45° FOV; CFP; image size 2048x1536 — 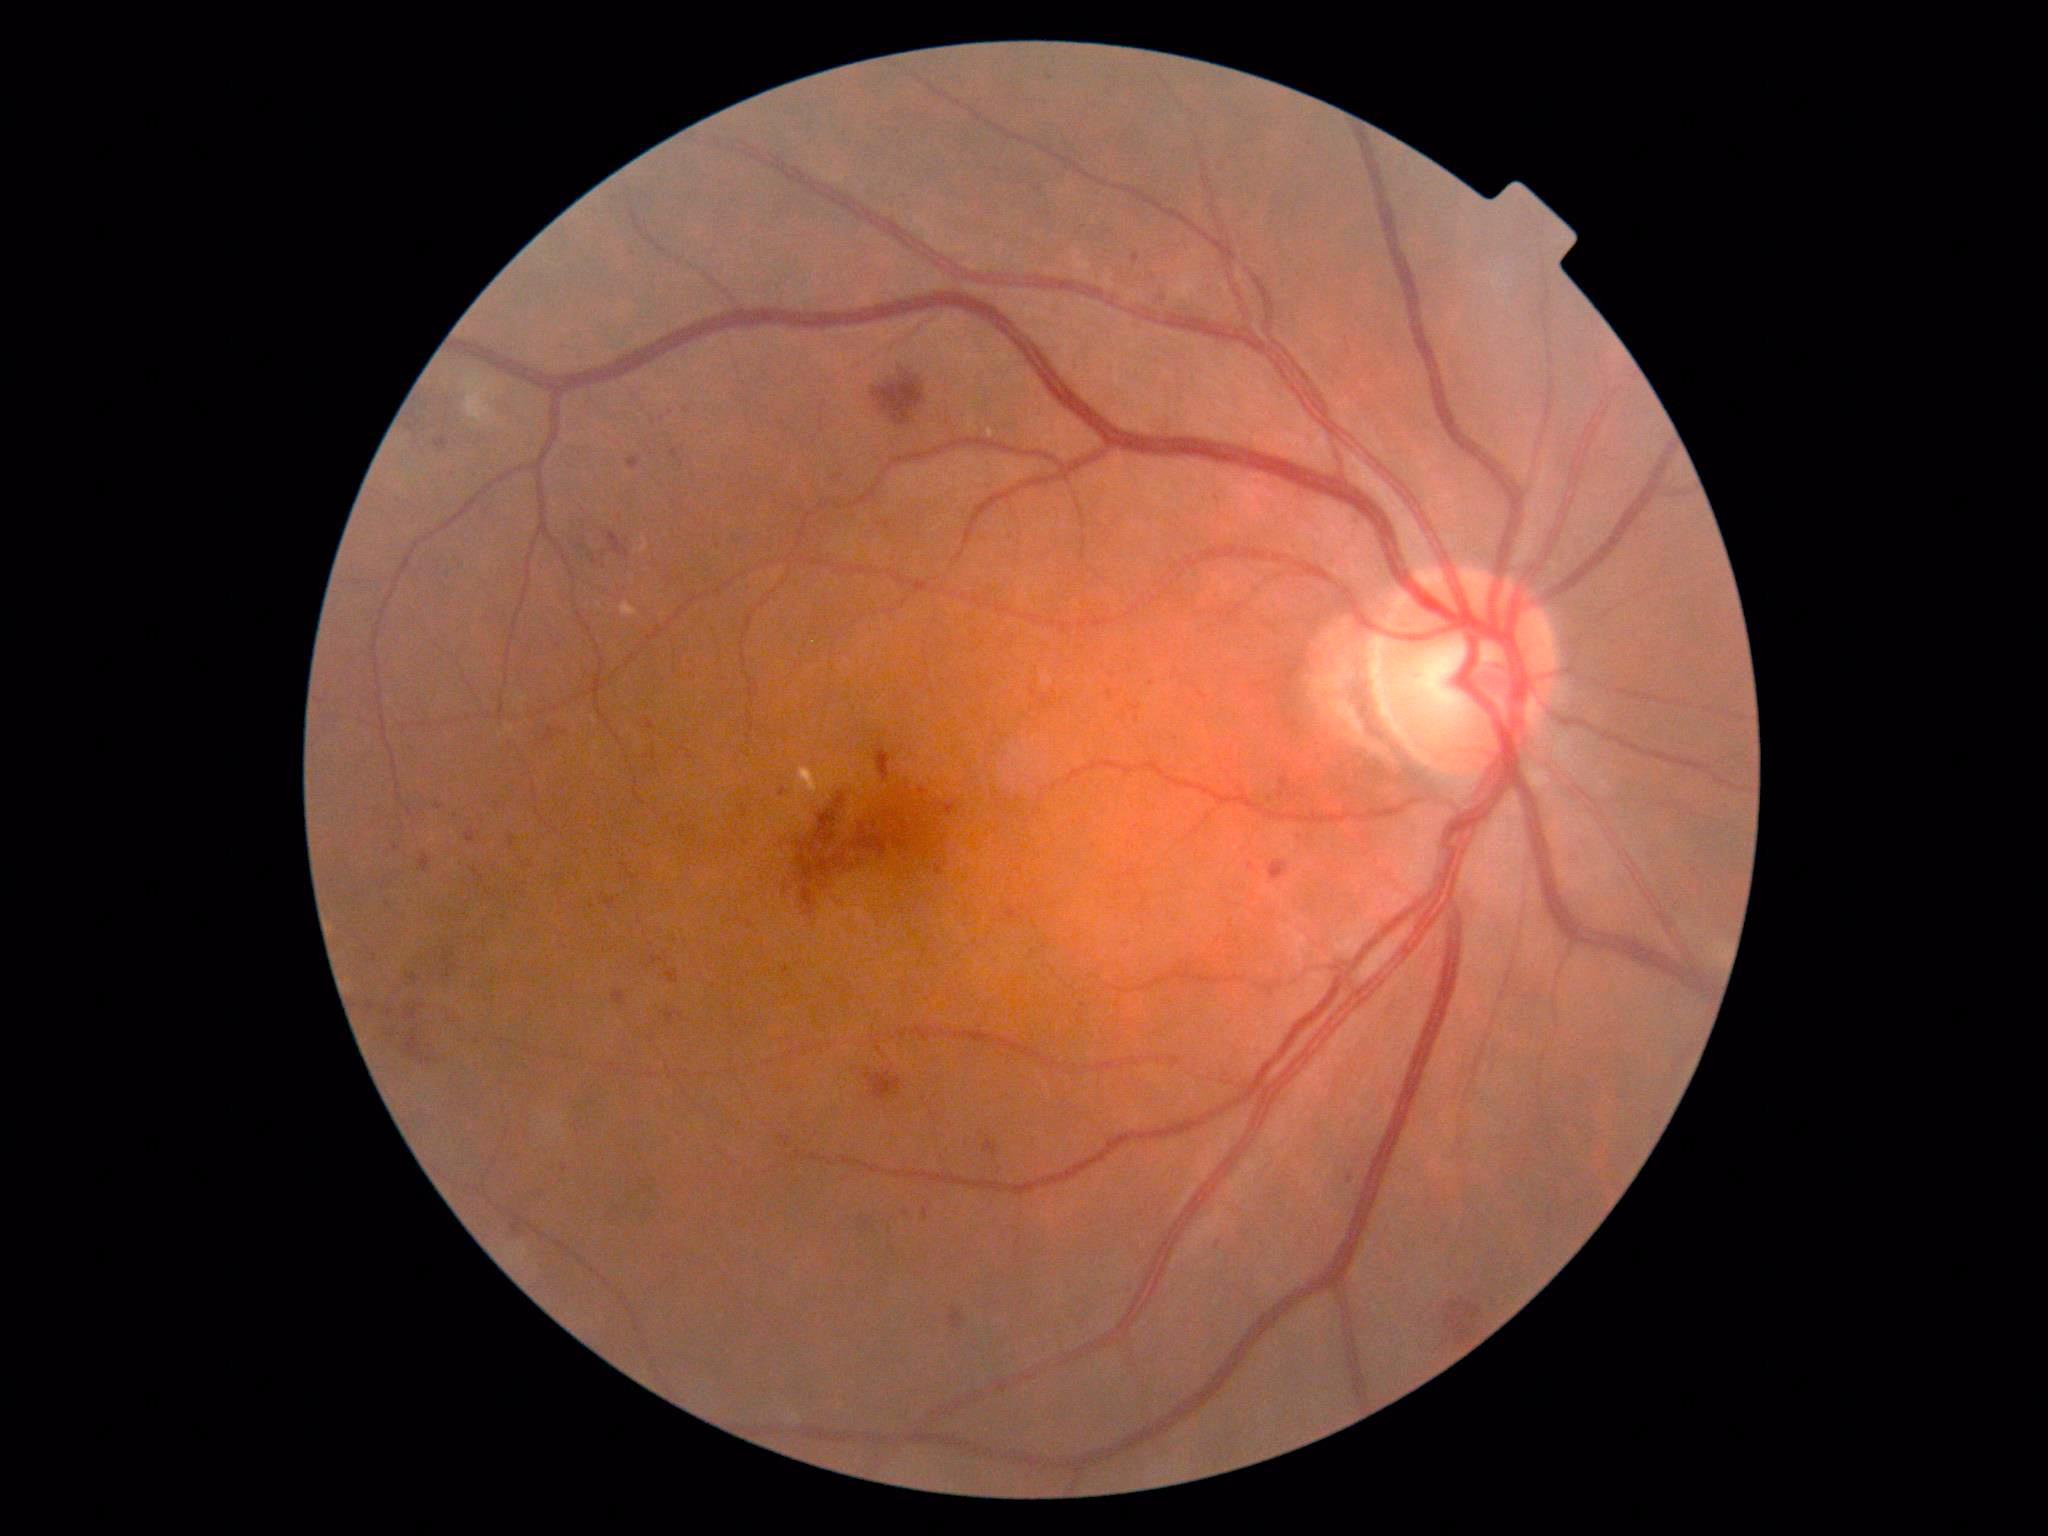

{
  "dr_category": "non-proliferative diabetic retinopathy",
  "dr_grade": "2 (moderate NPDR)"
}